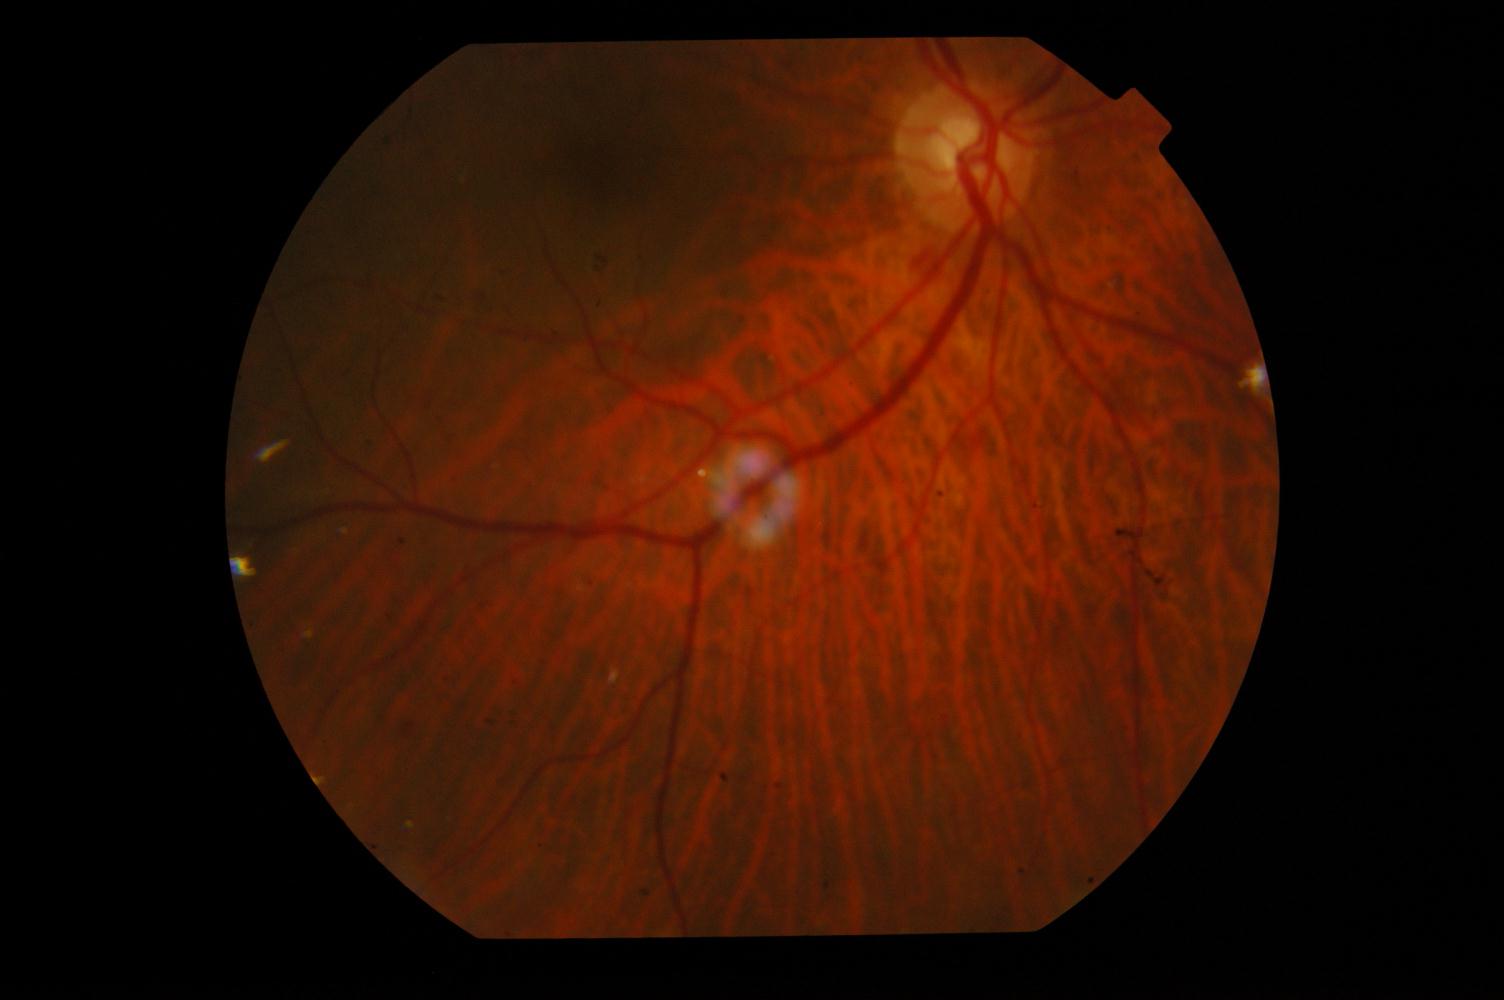 There is evidence of DR (diabetic retinopathy).